NIDEK AFC-230 fundus camera, Davis DR grading, 848x848:
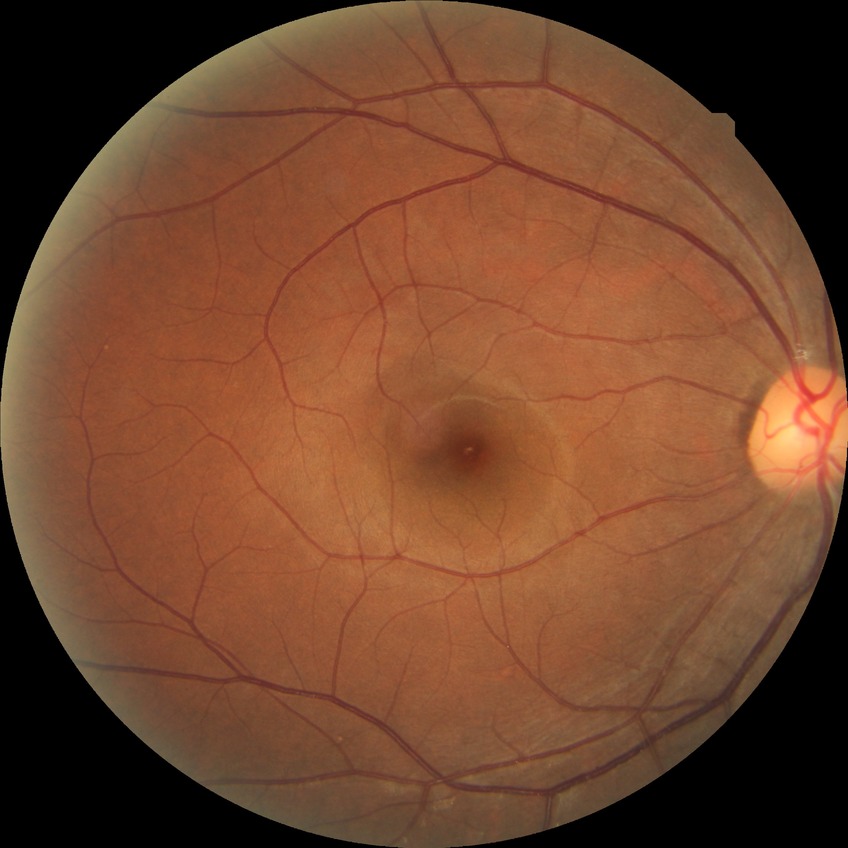

Modified Davis grading: no diabetic retinopathy.